Without pupil dilation, 848 by 848 pixels, posterior pole color fundus photograph, FOV: 45 degrees.
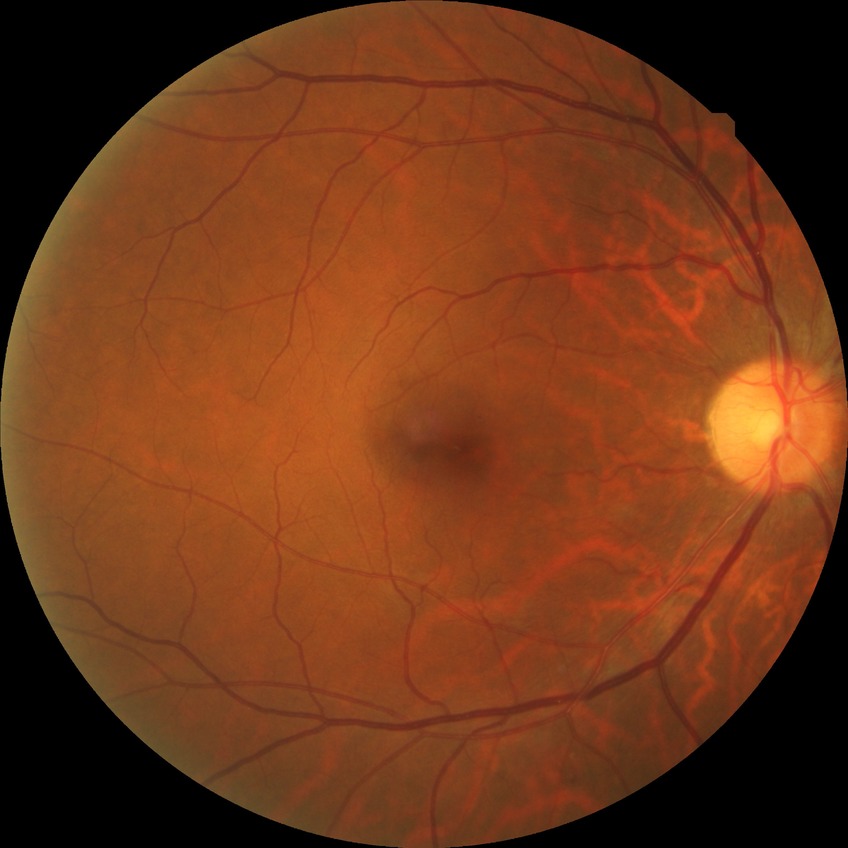 diabetic retinopathy (DR) = NDR (no diabetic retinopathy).